Color fundus photograph. Disc-centered field — 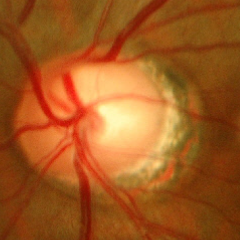
Showing no evidence of glaucoma.